45° FOV, color fundus photograph.
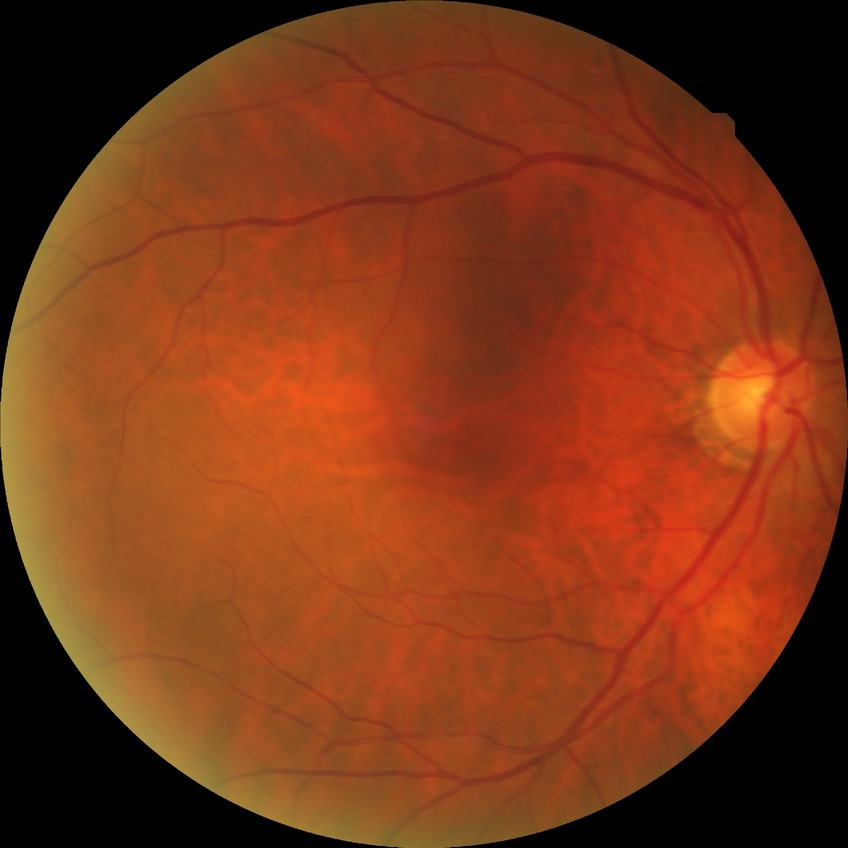
Diabetic retinopathy (DR) is NDR (no diabetic retinopathy).